Natus RetCam Envision, 130° FOV · infant wide-field retinal image · 1440 x 1080 pixels
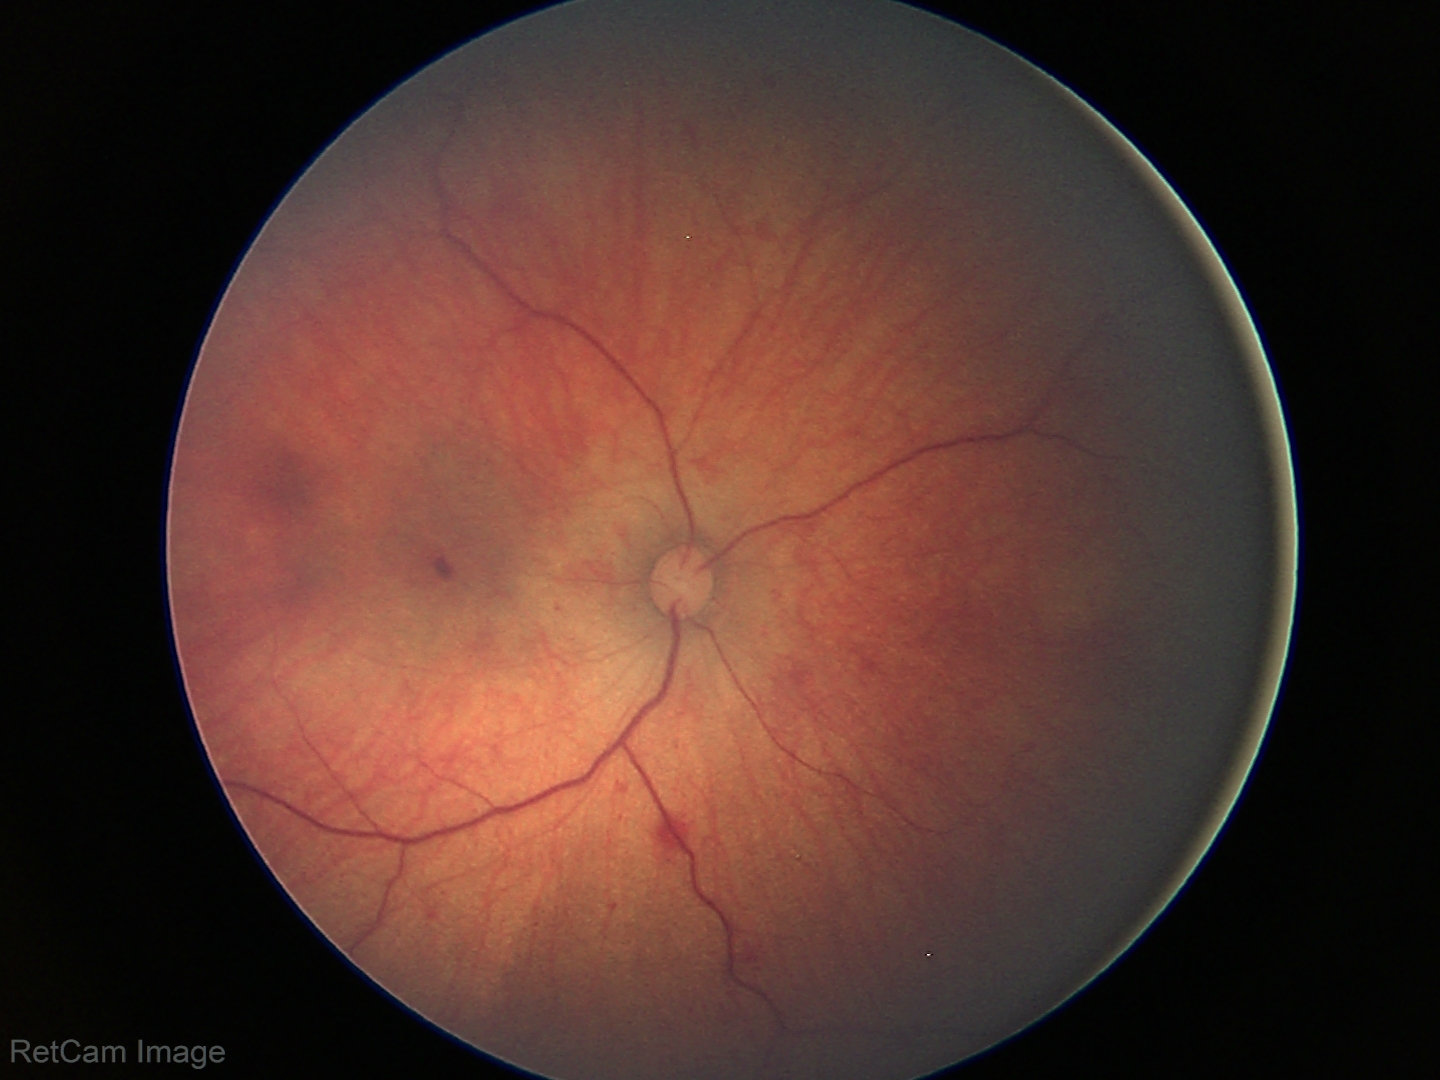 Examination diagnosed as retinal hemorrhages.